Fundus photo.
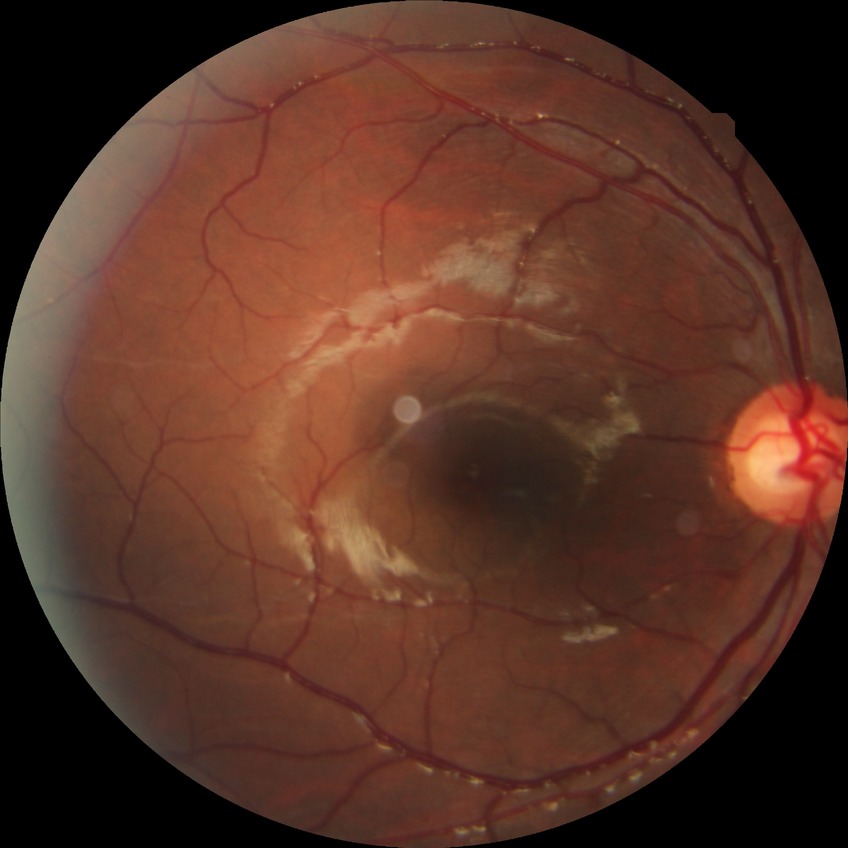

Findings:
- modified Davis grade — NDR